Color fundus image: 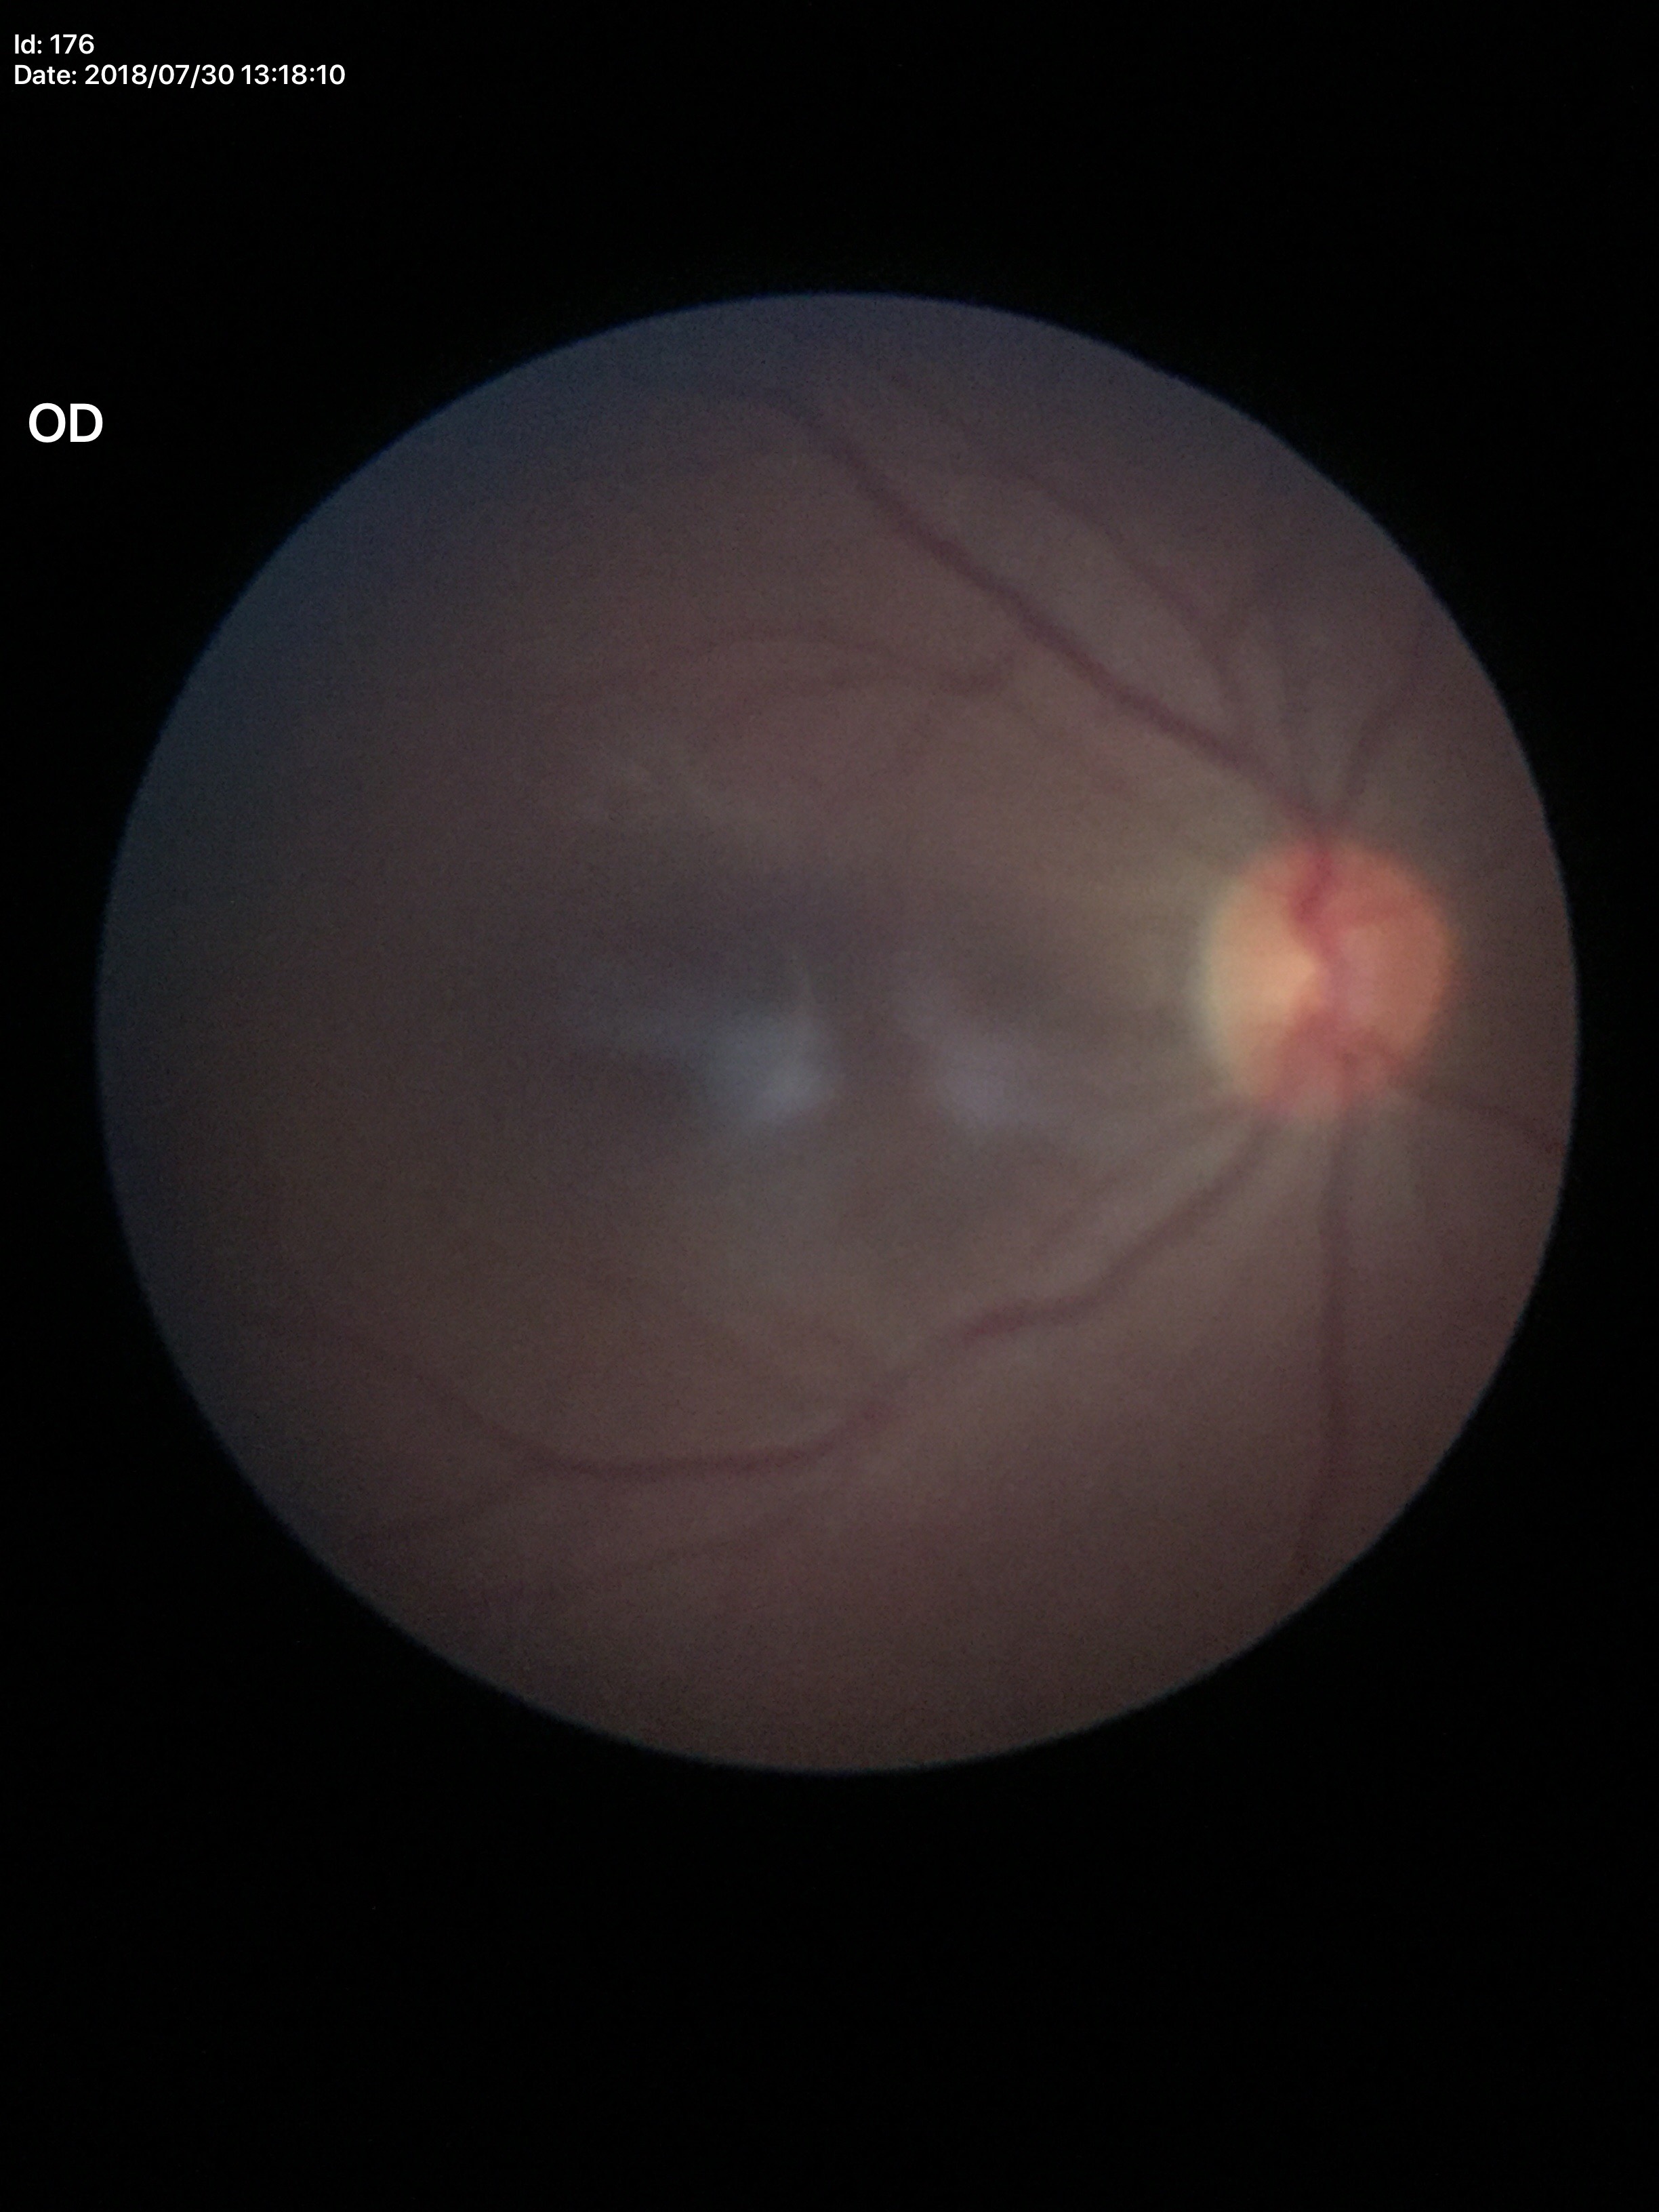
Glaucoma impression: negative.
Vertical CDR (VCDR): 0.47.